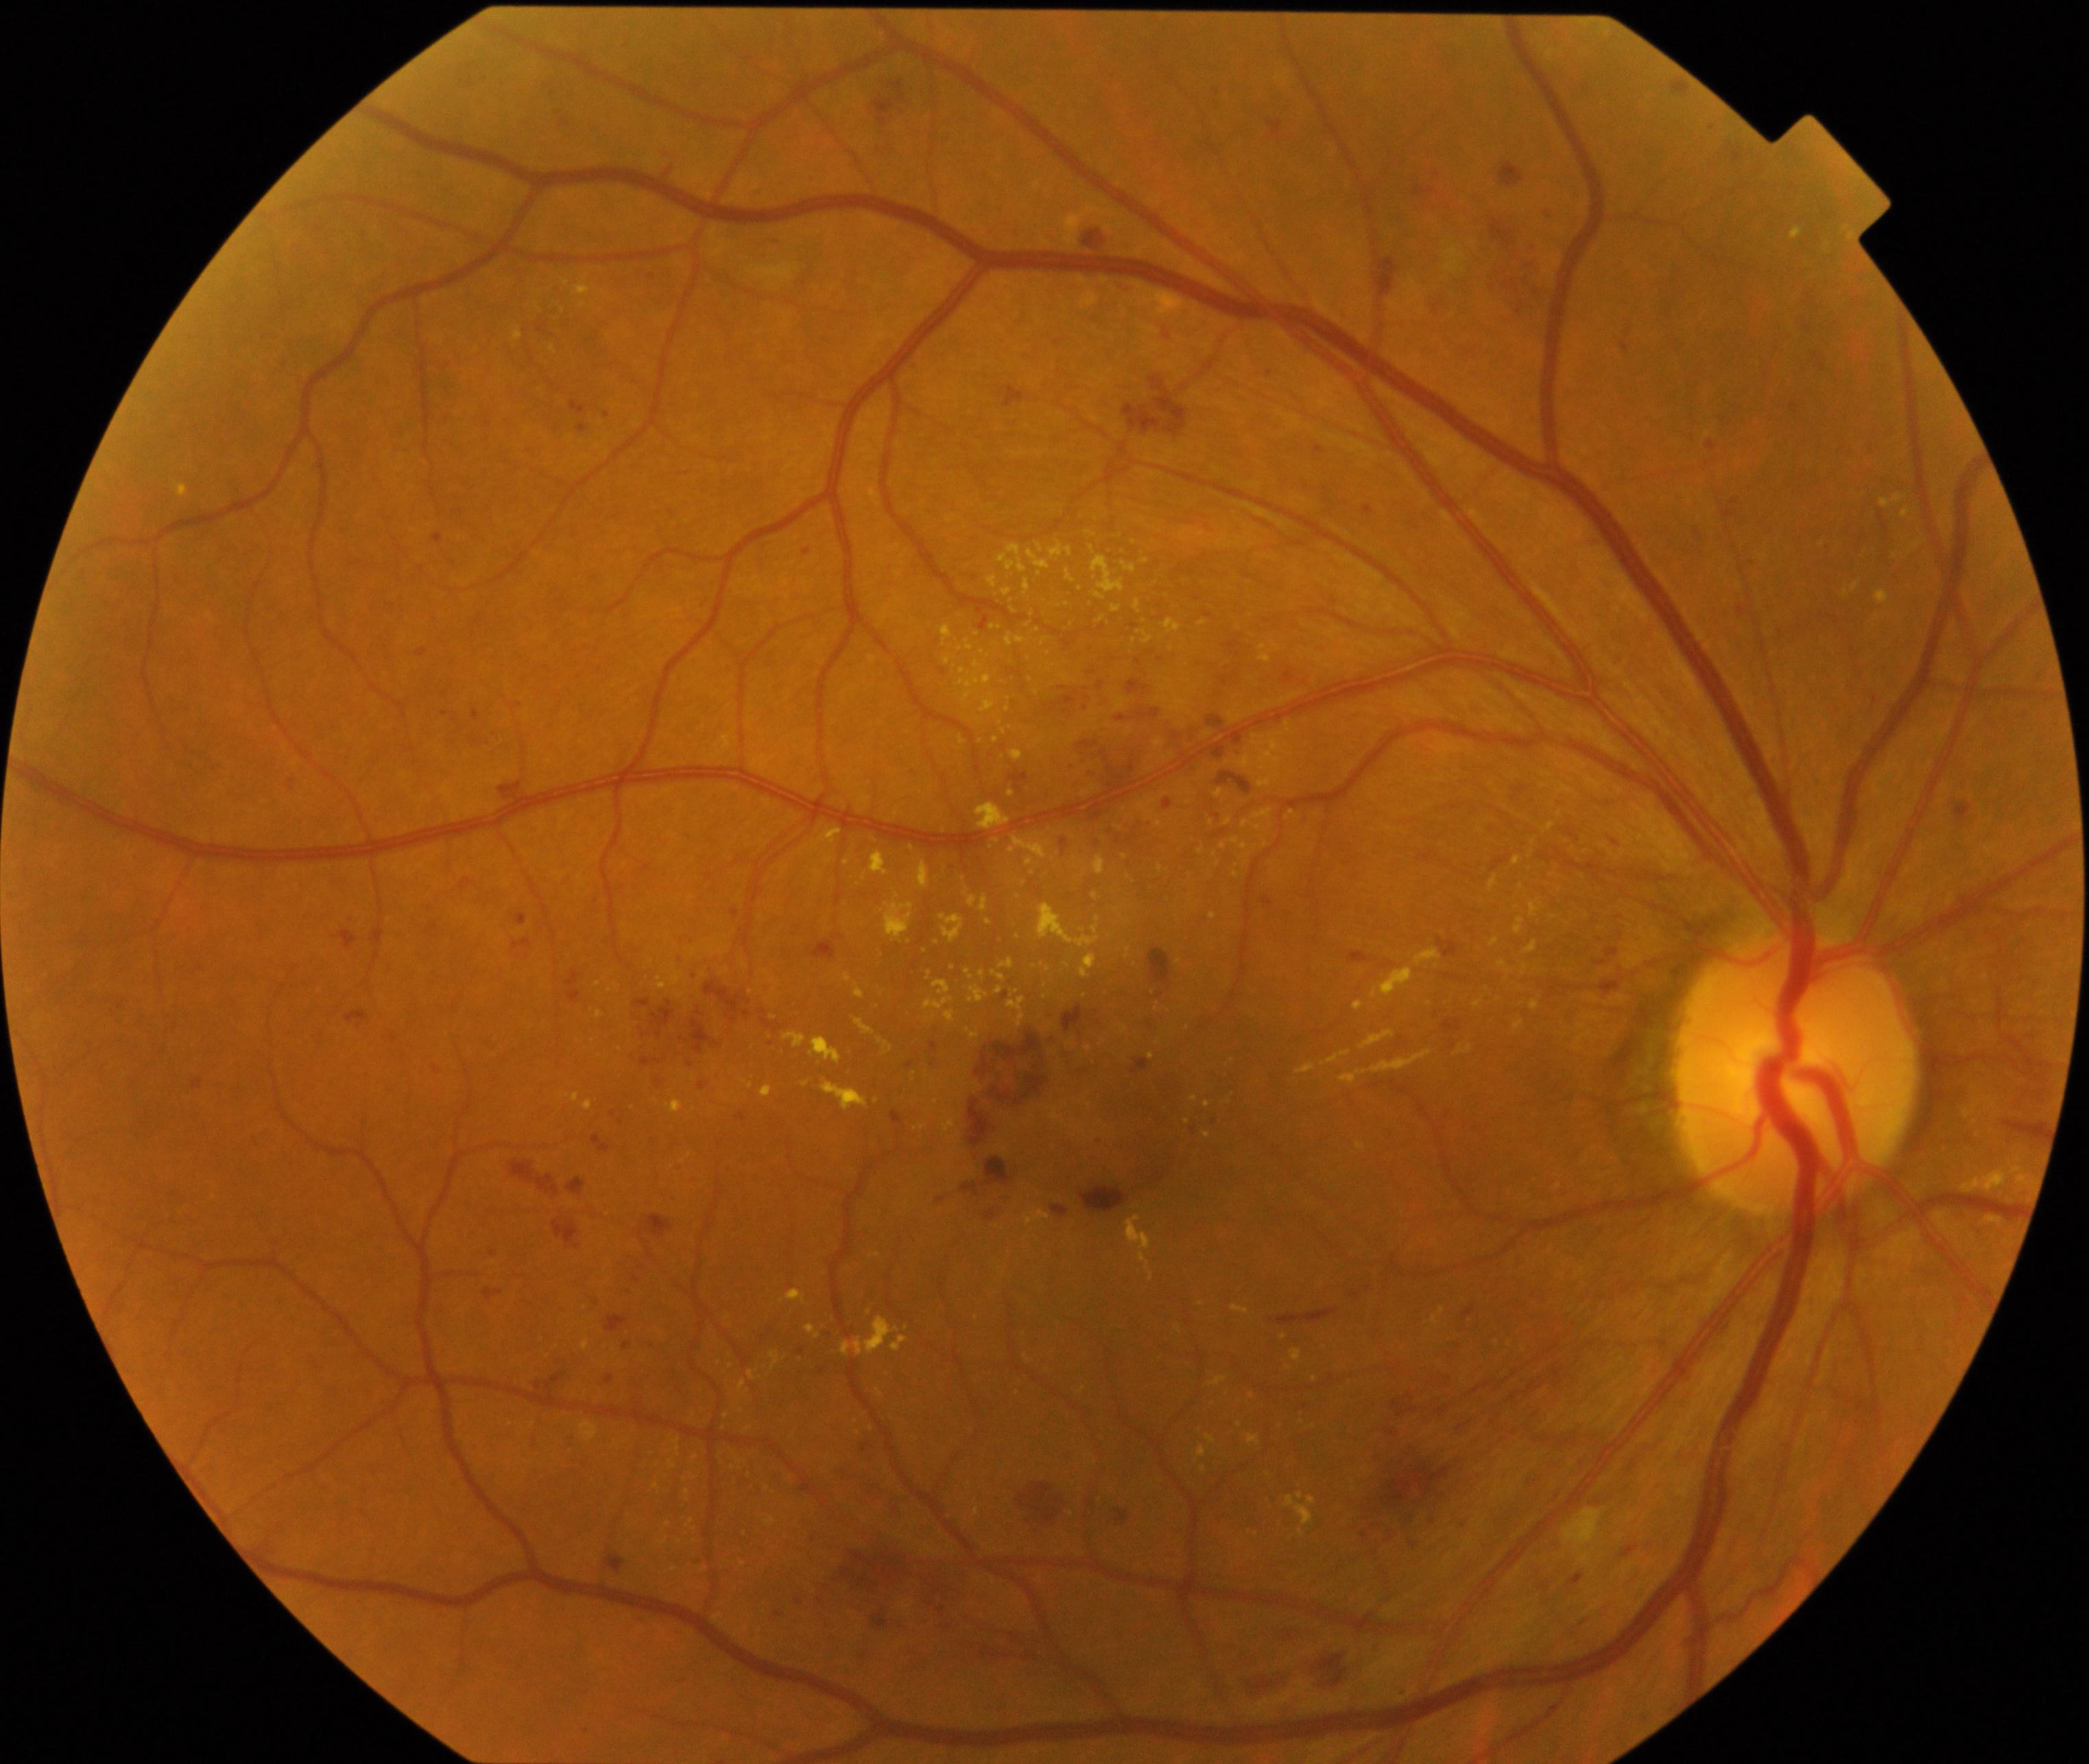 Findings: moderate non-proliferative diabetic retinopathy.